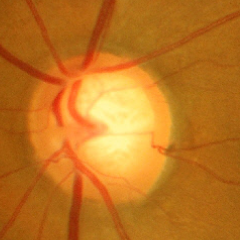 Glaucoma assessment: early glaucomatous changes.